Fundus photo:
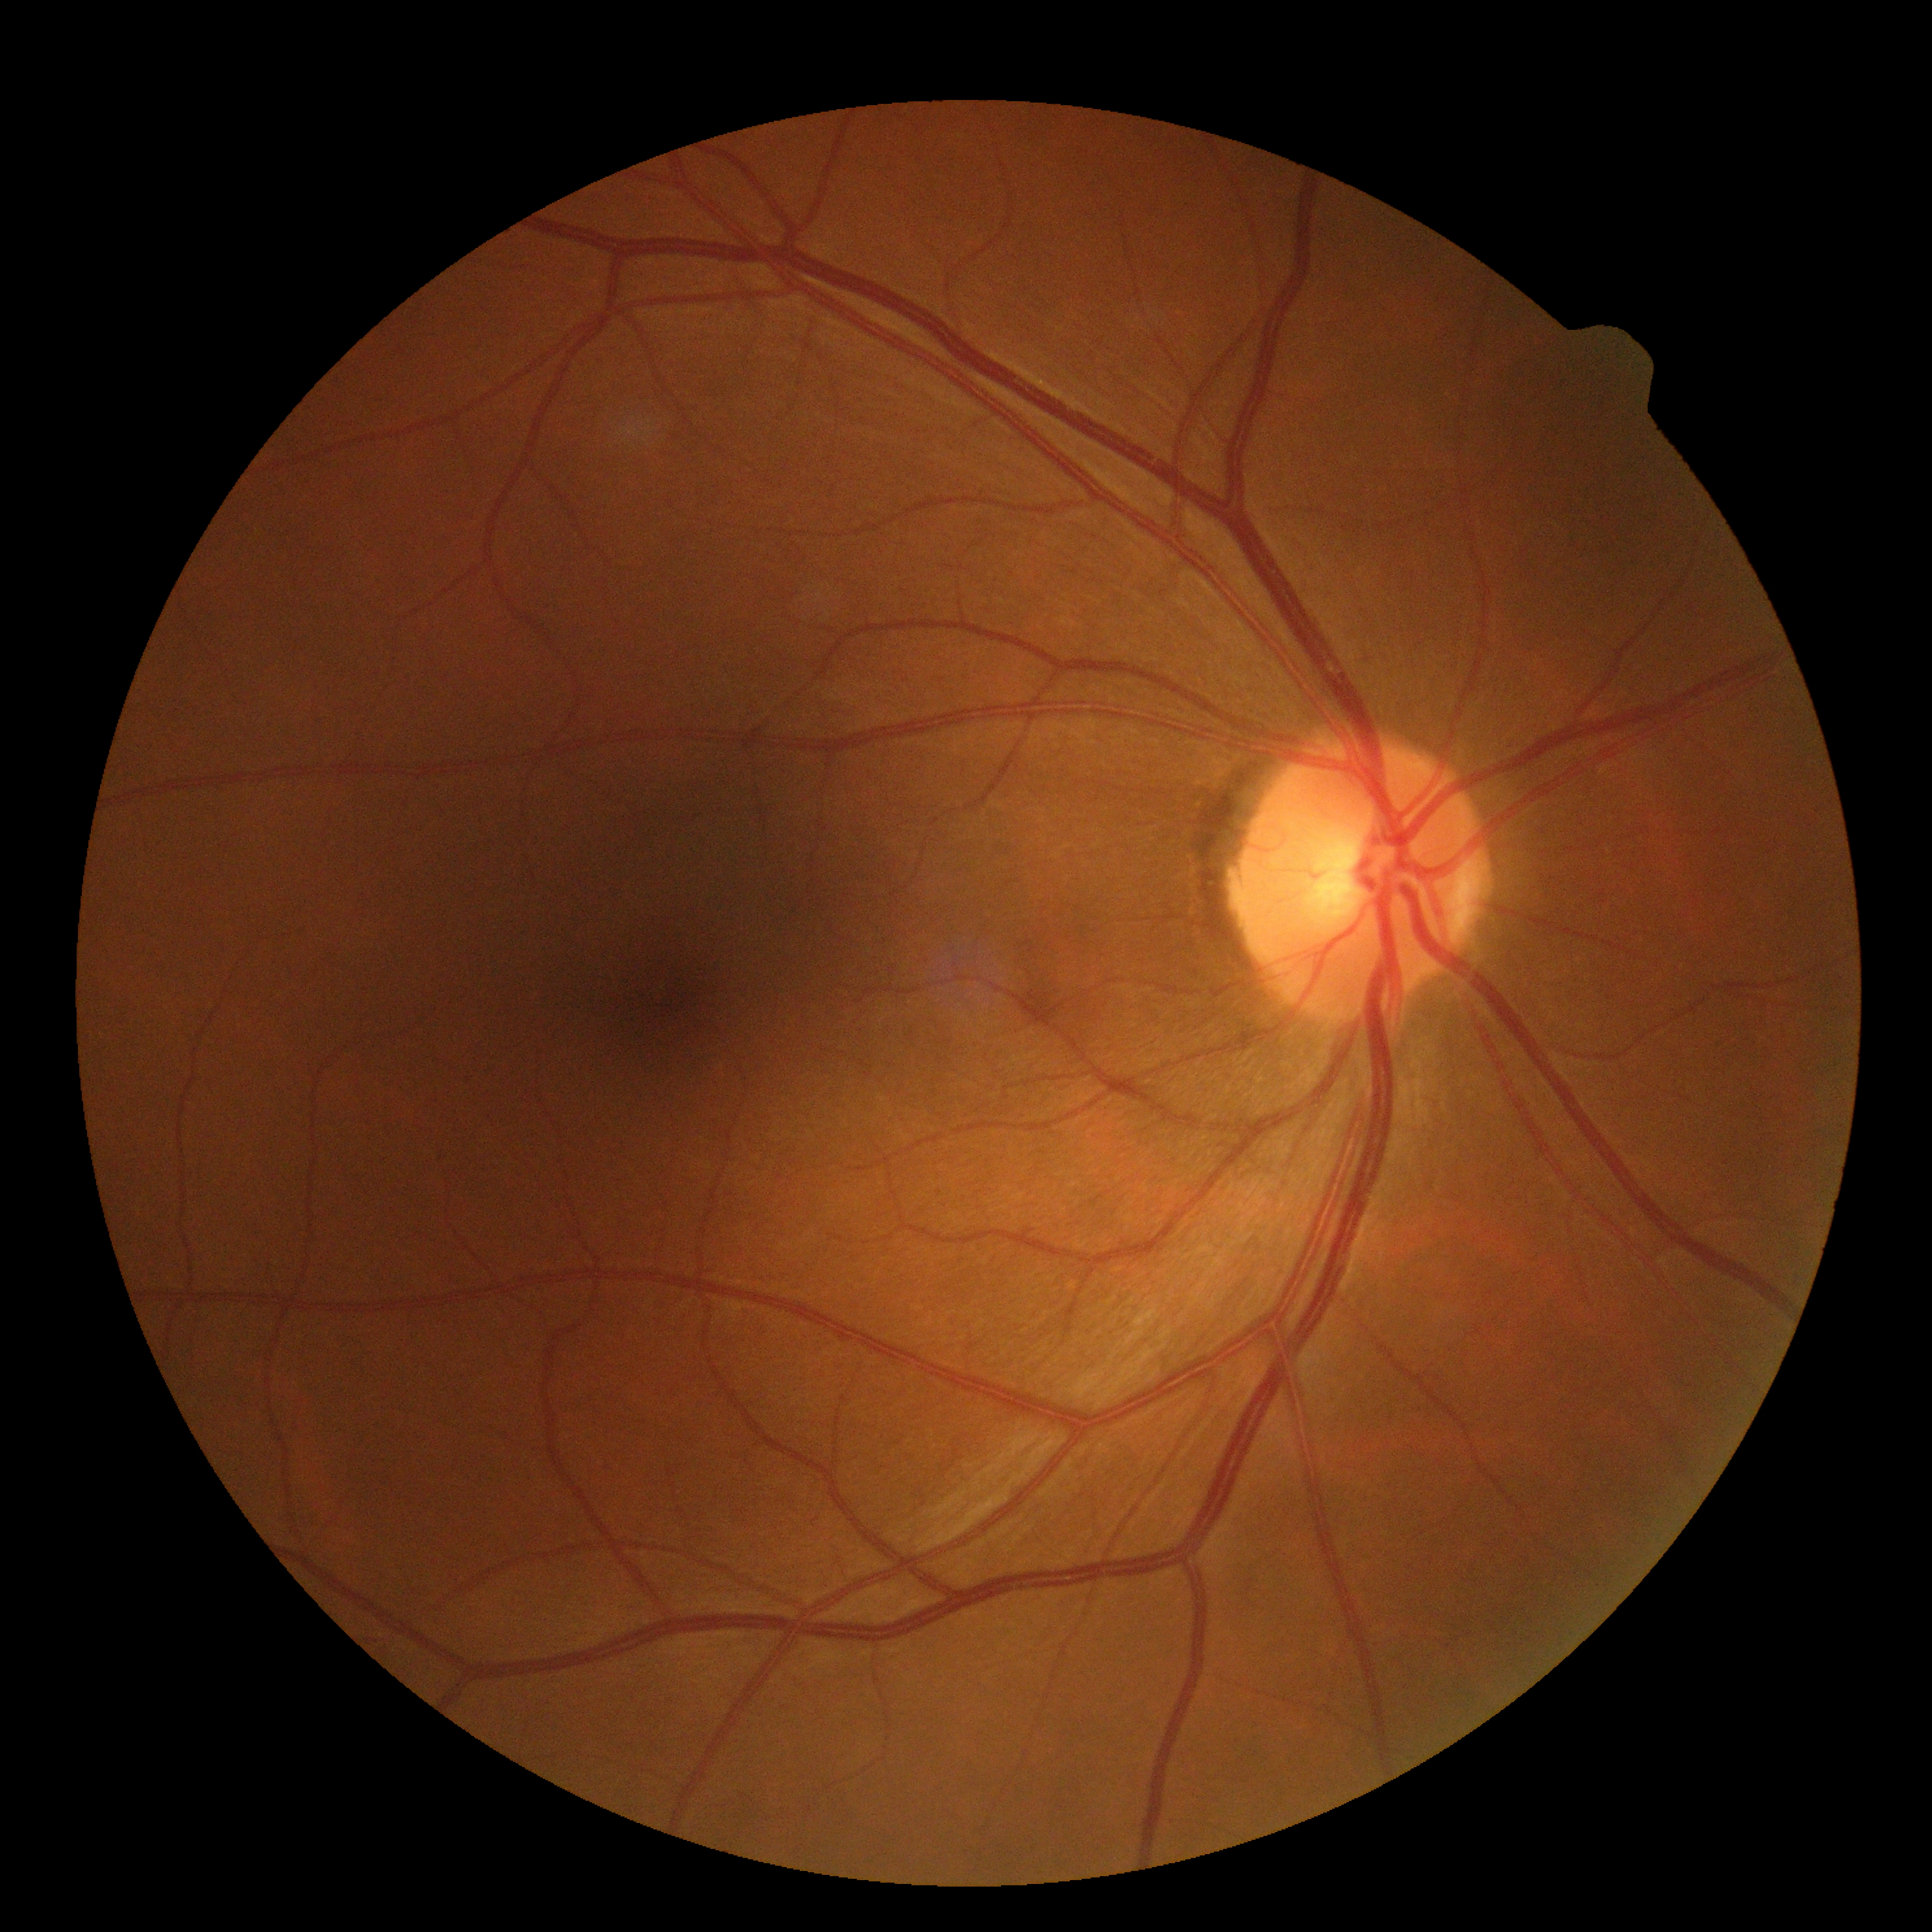
  dr_impression: no signs of DR
  dr_grade: 0